Posterior pole color fundus photograph · NIDEK AFC-230 · without pupil dilation:
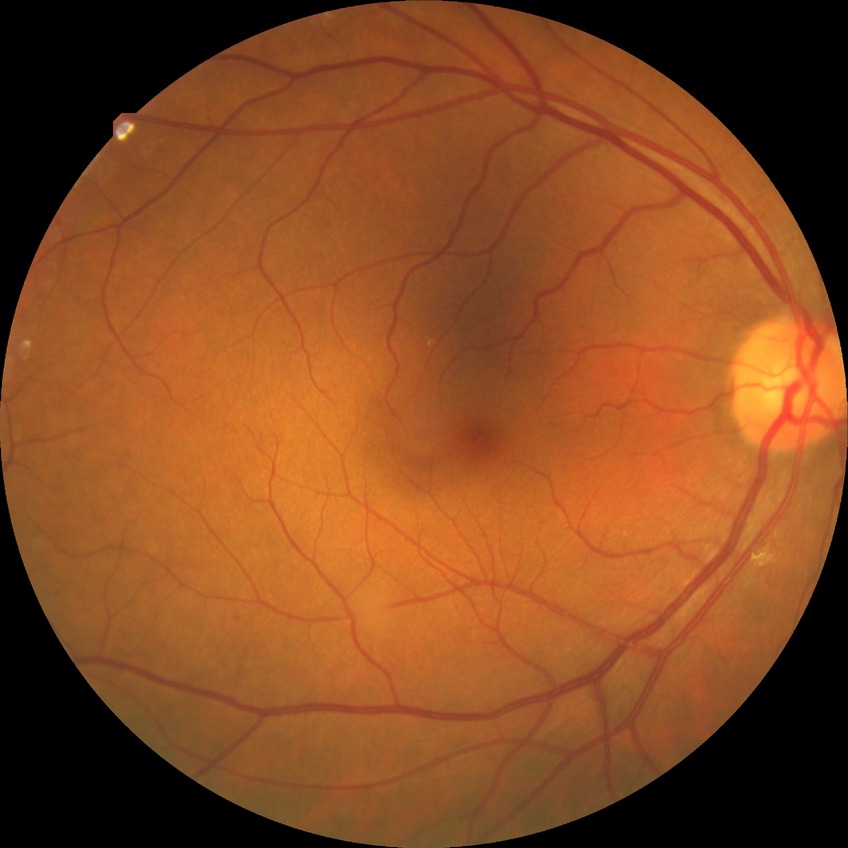 Retinopathy grade: no diabetic retinopathy.